45° field of view — 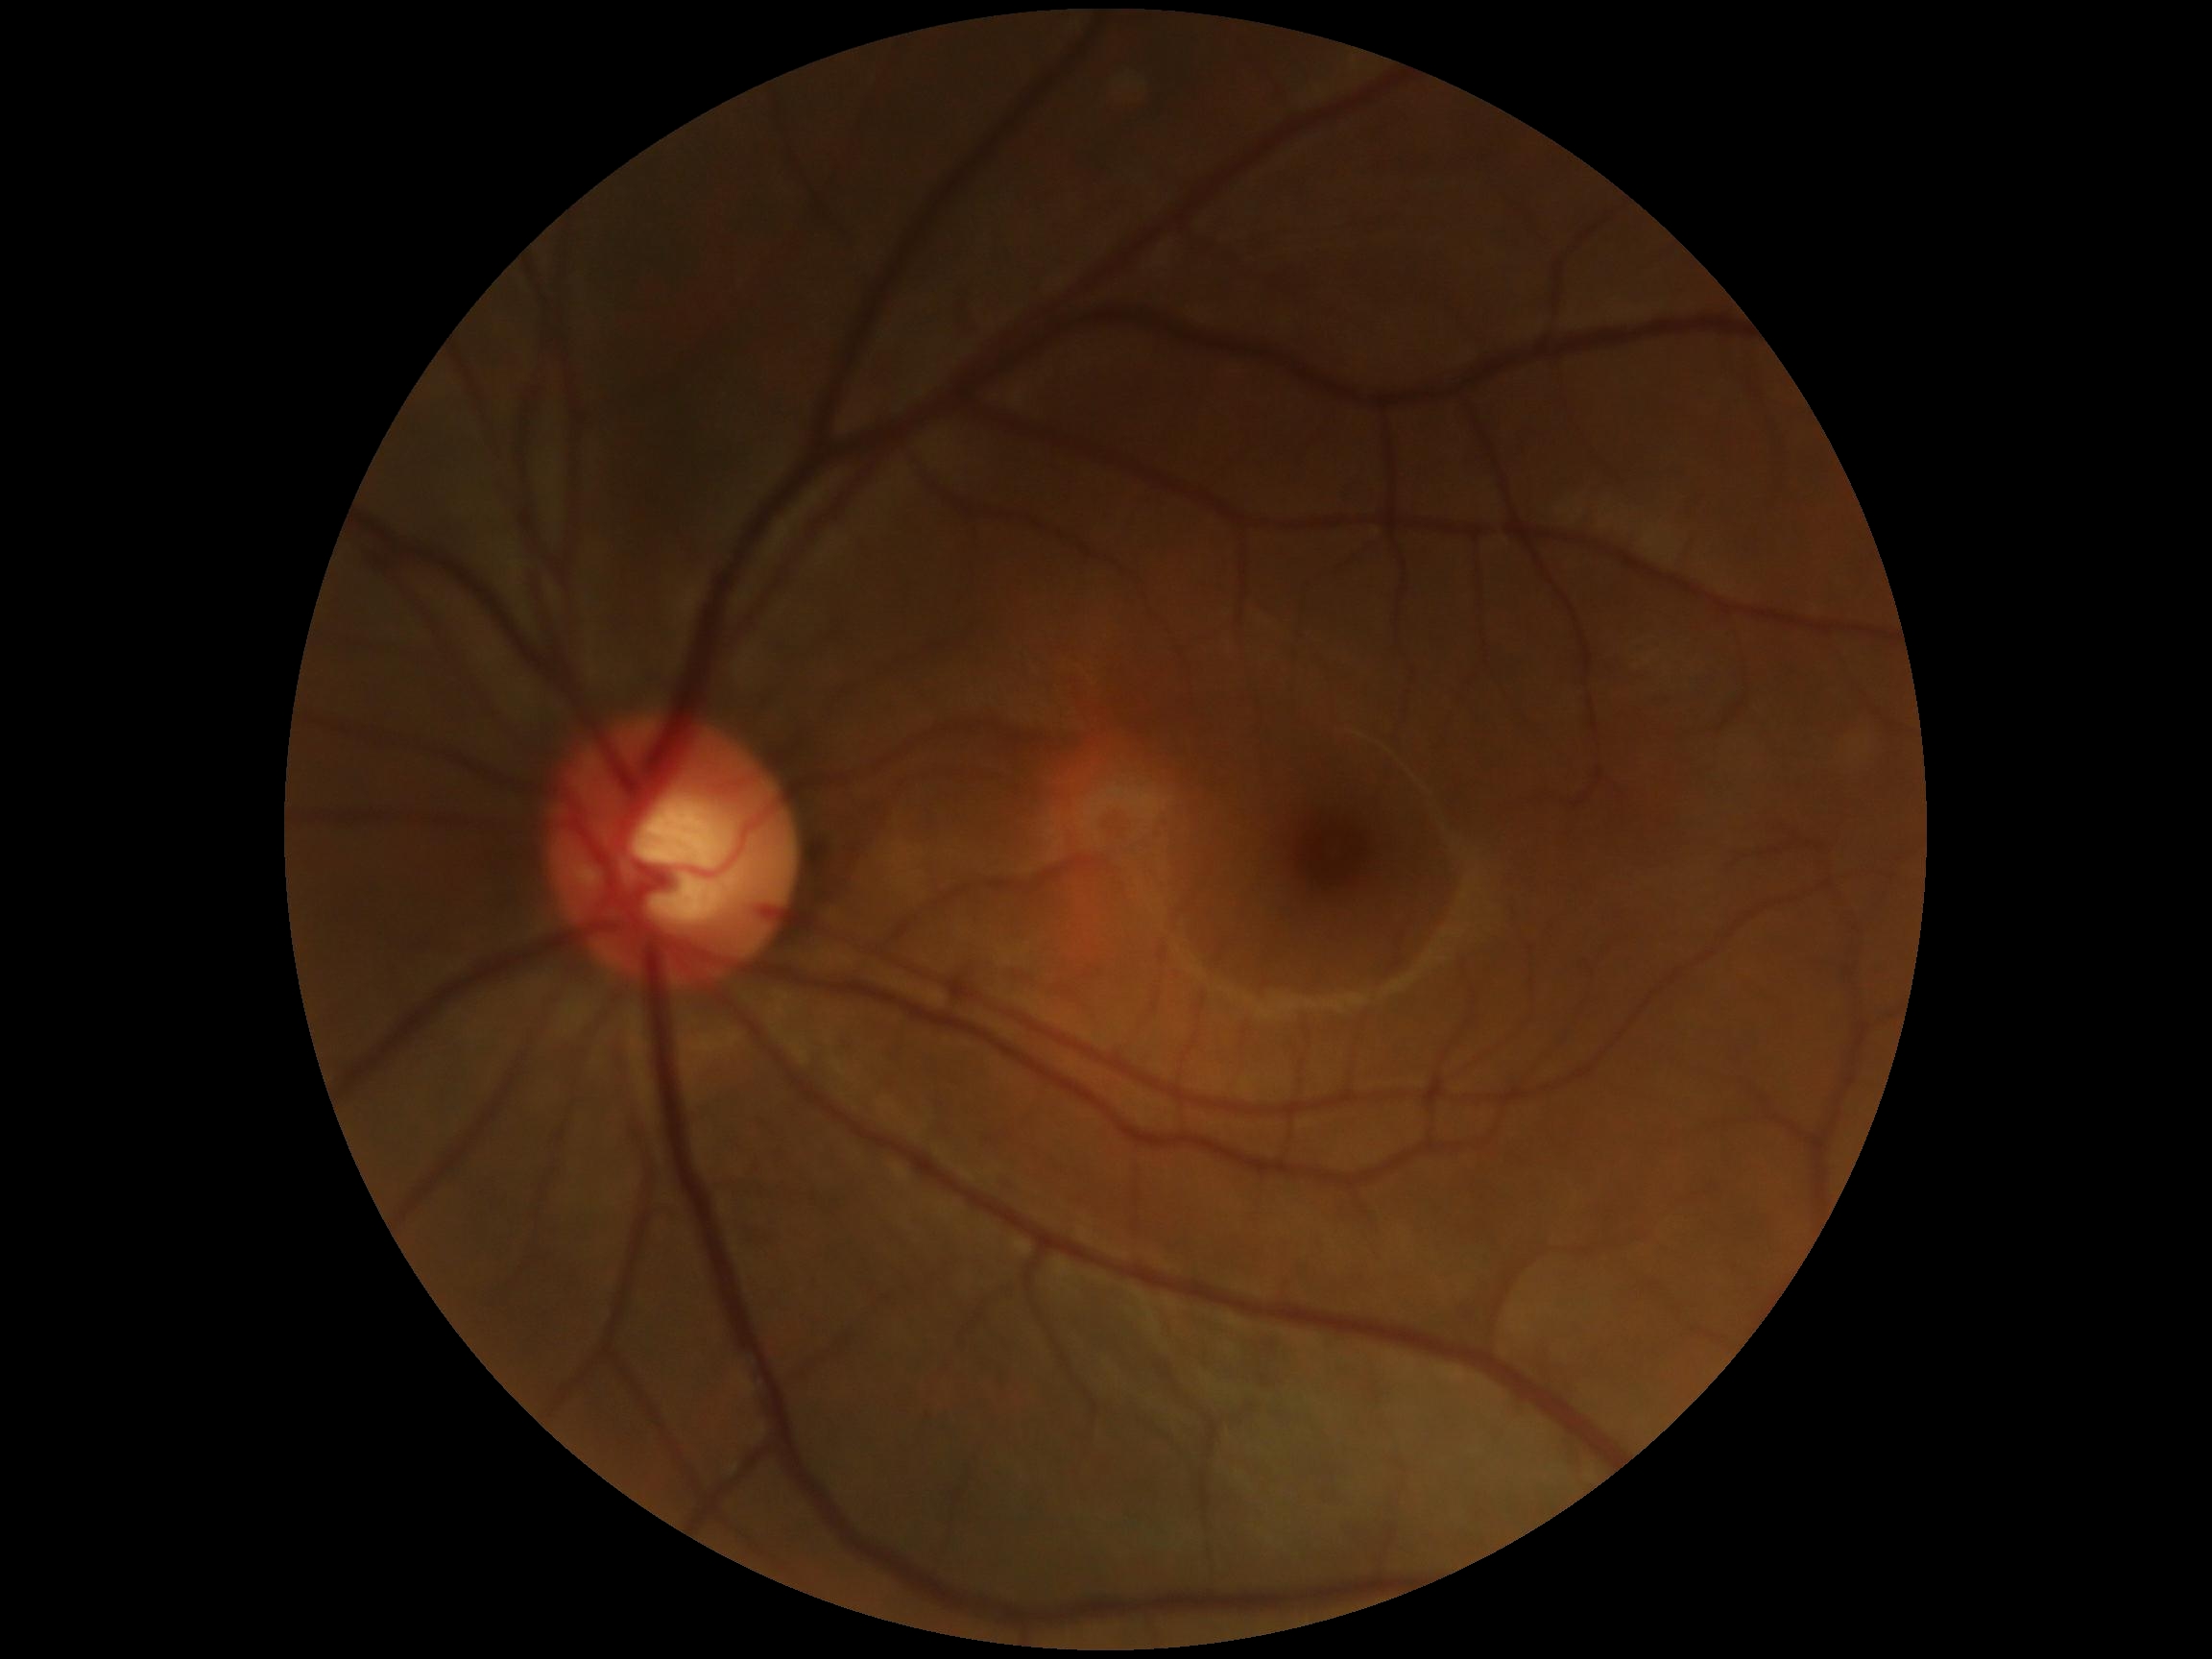
No DR findings.
DR stage is grade 0.